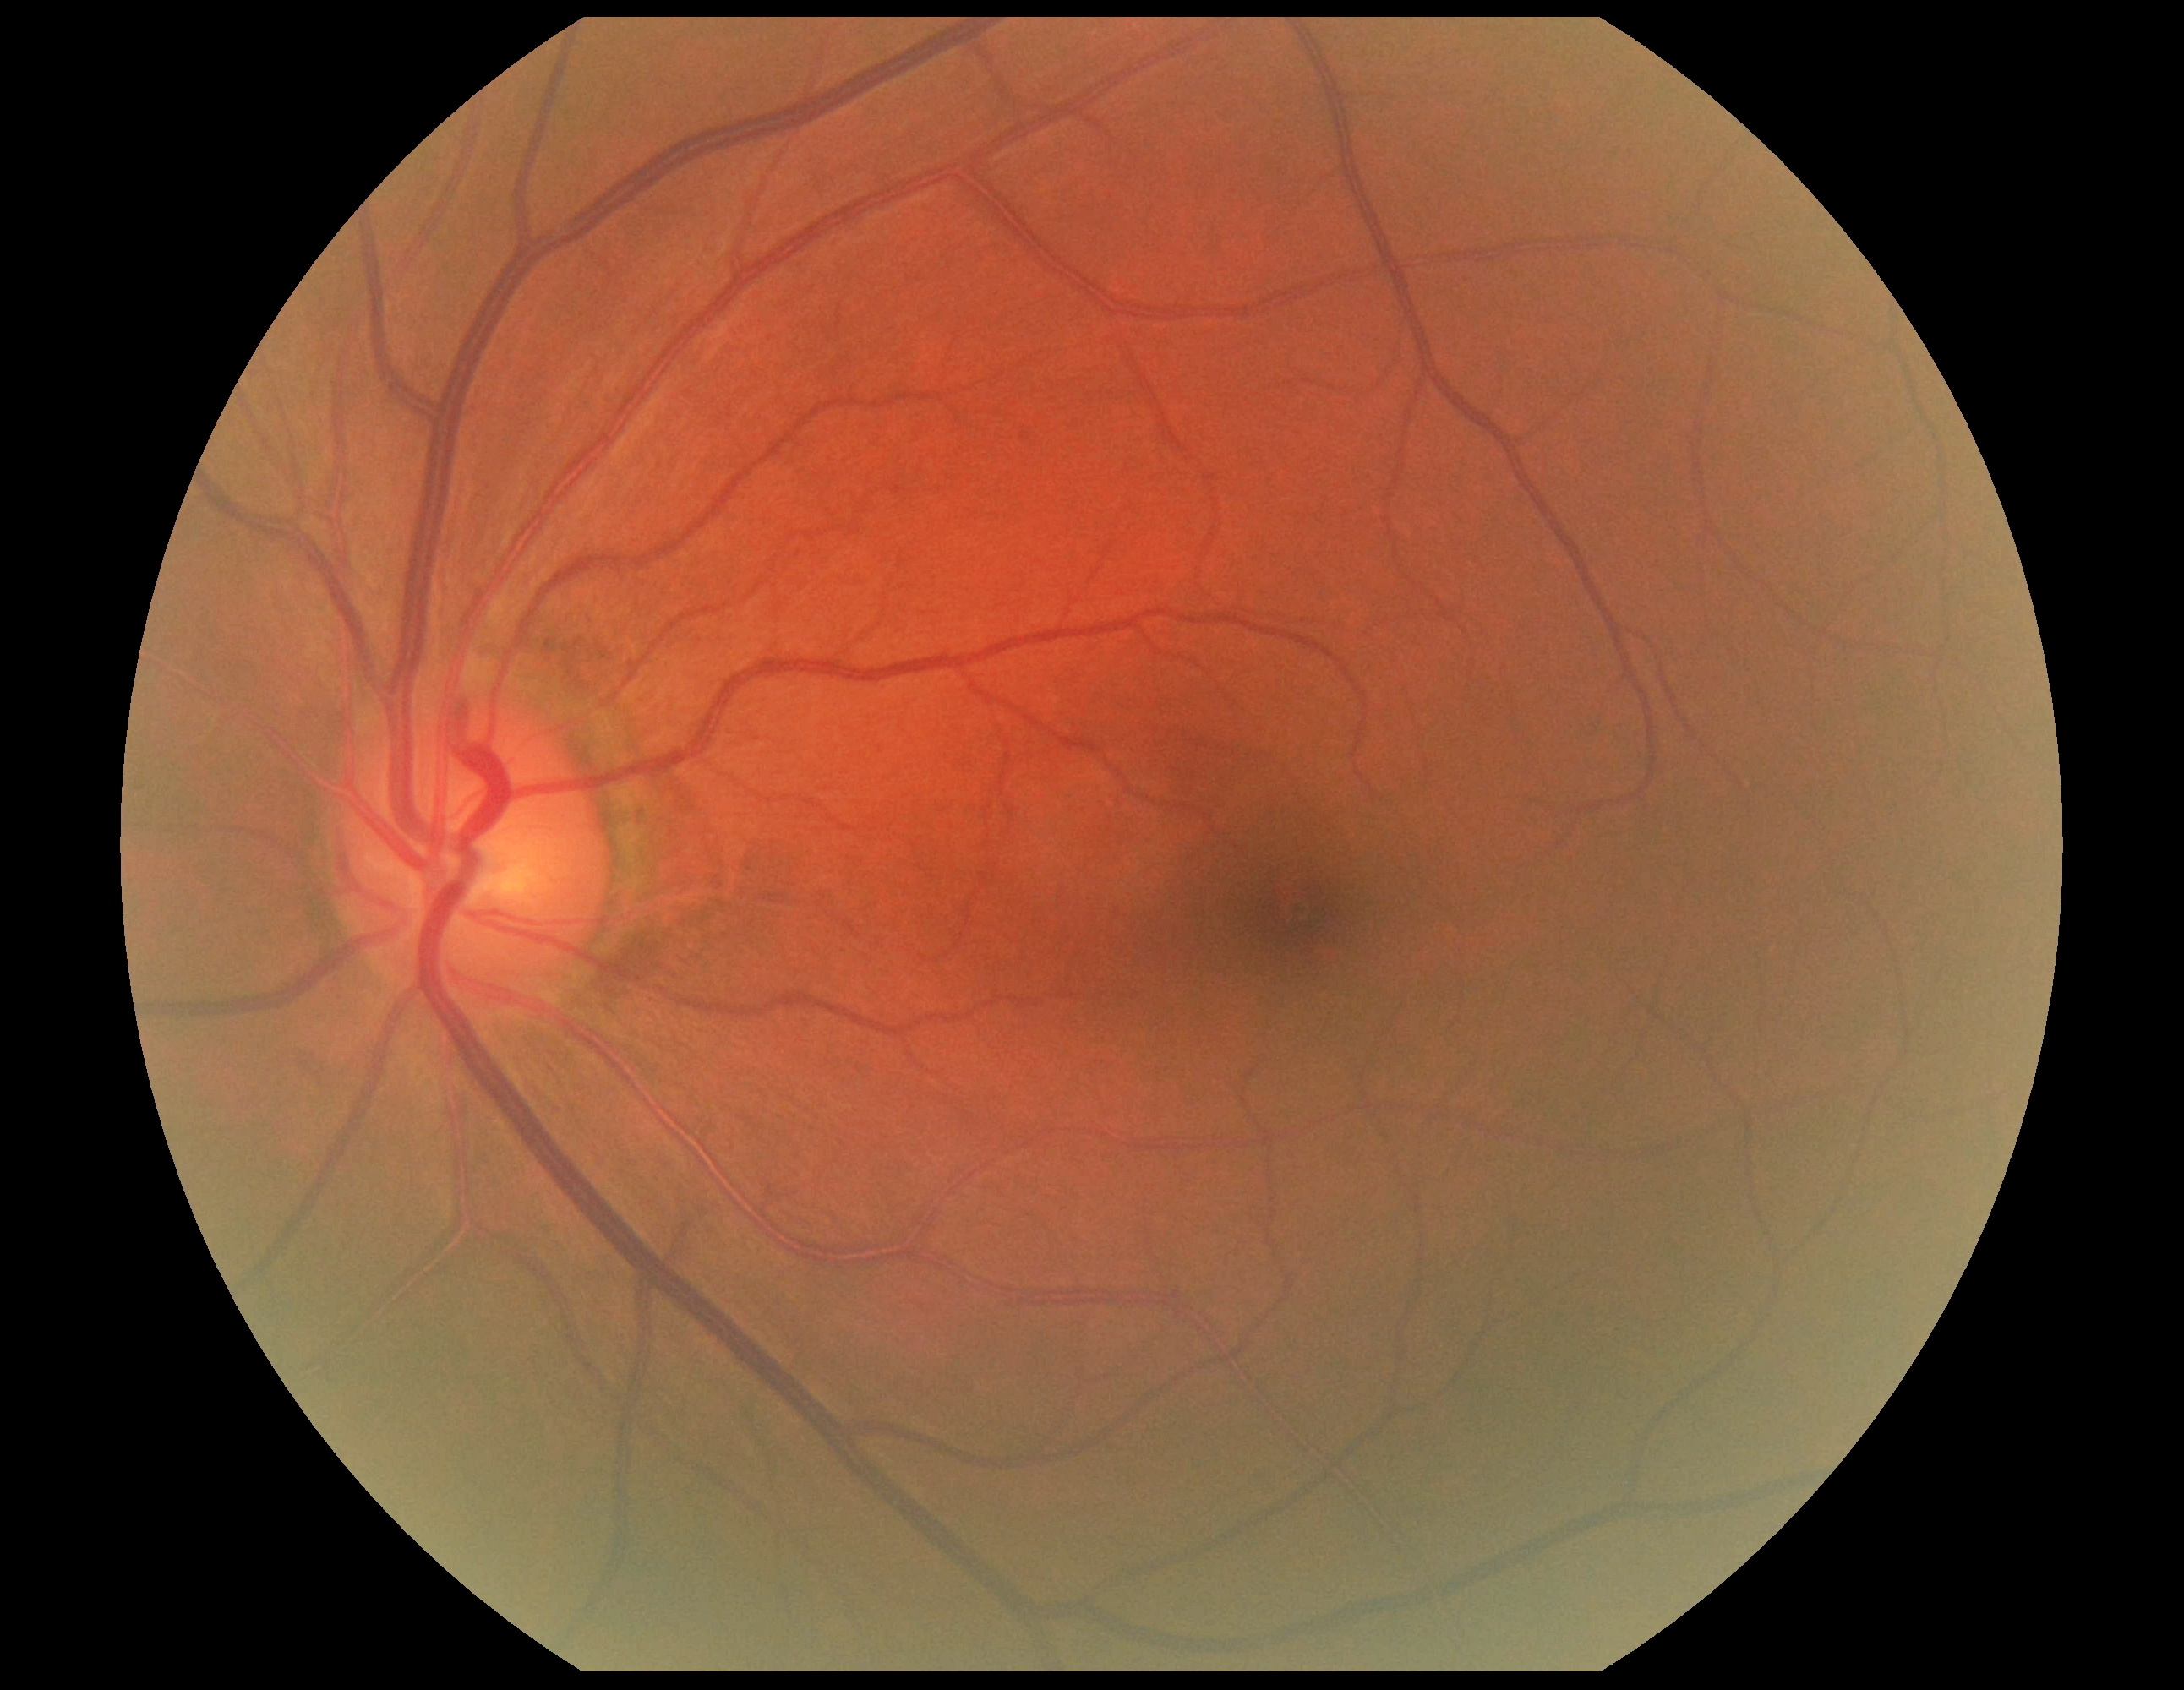 DR stage: 0.